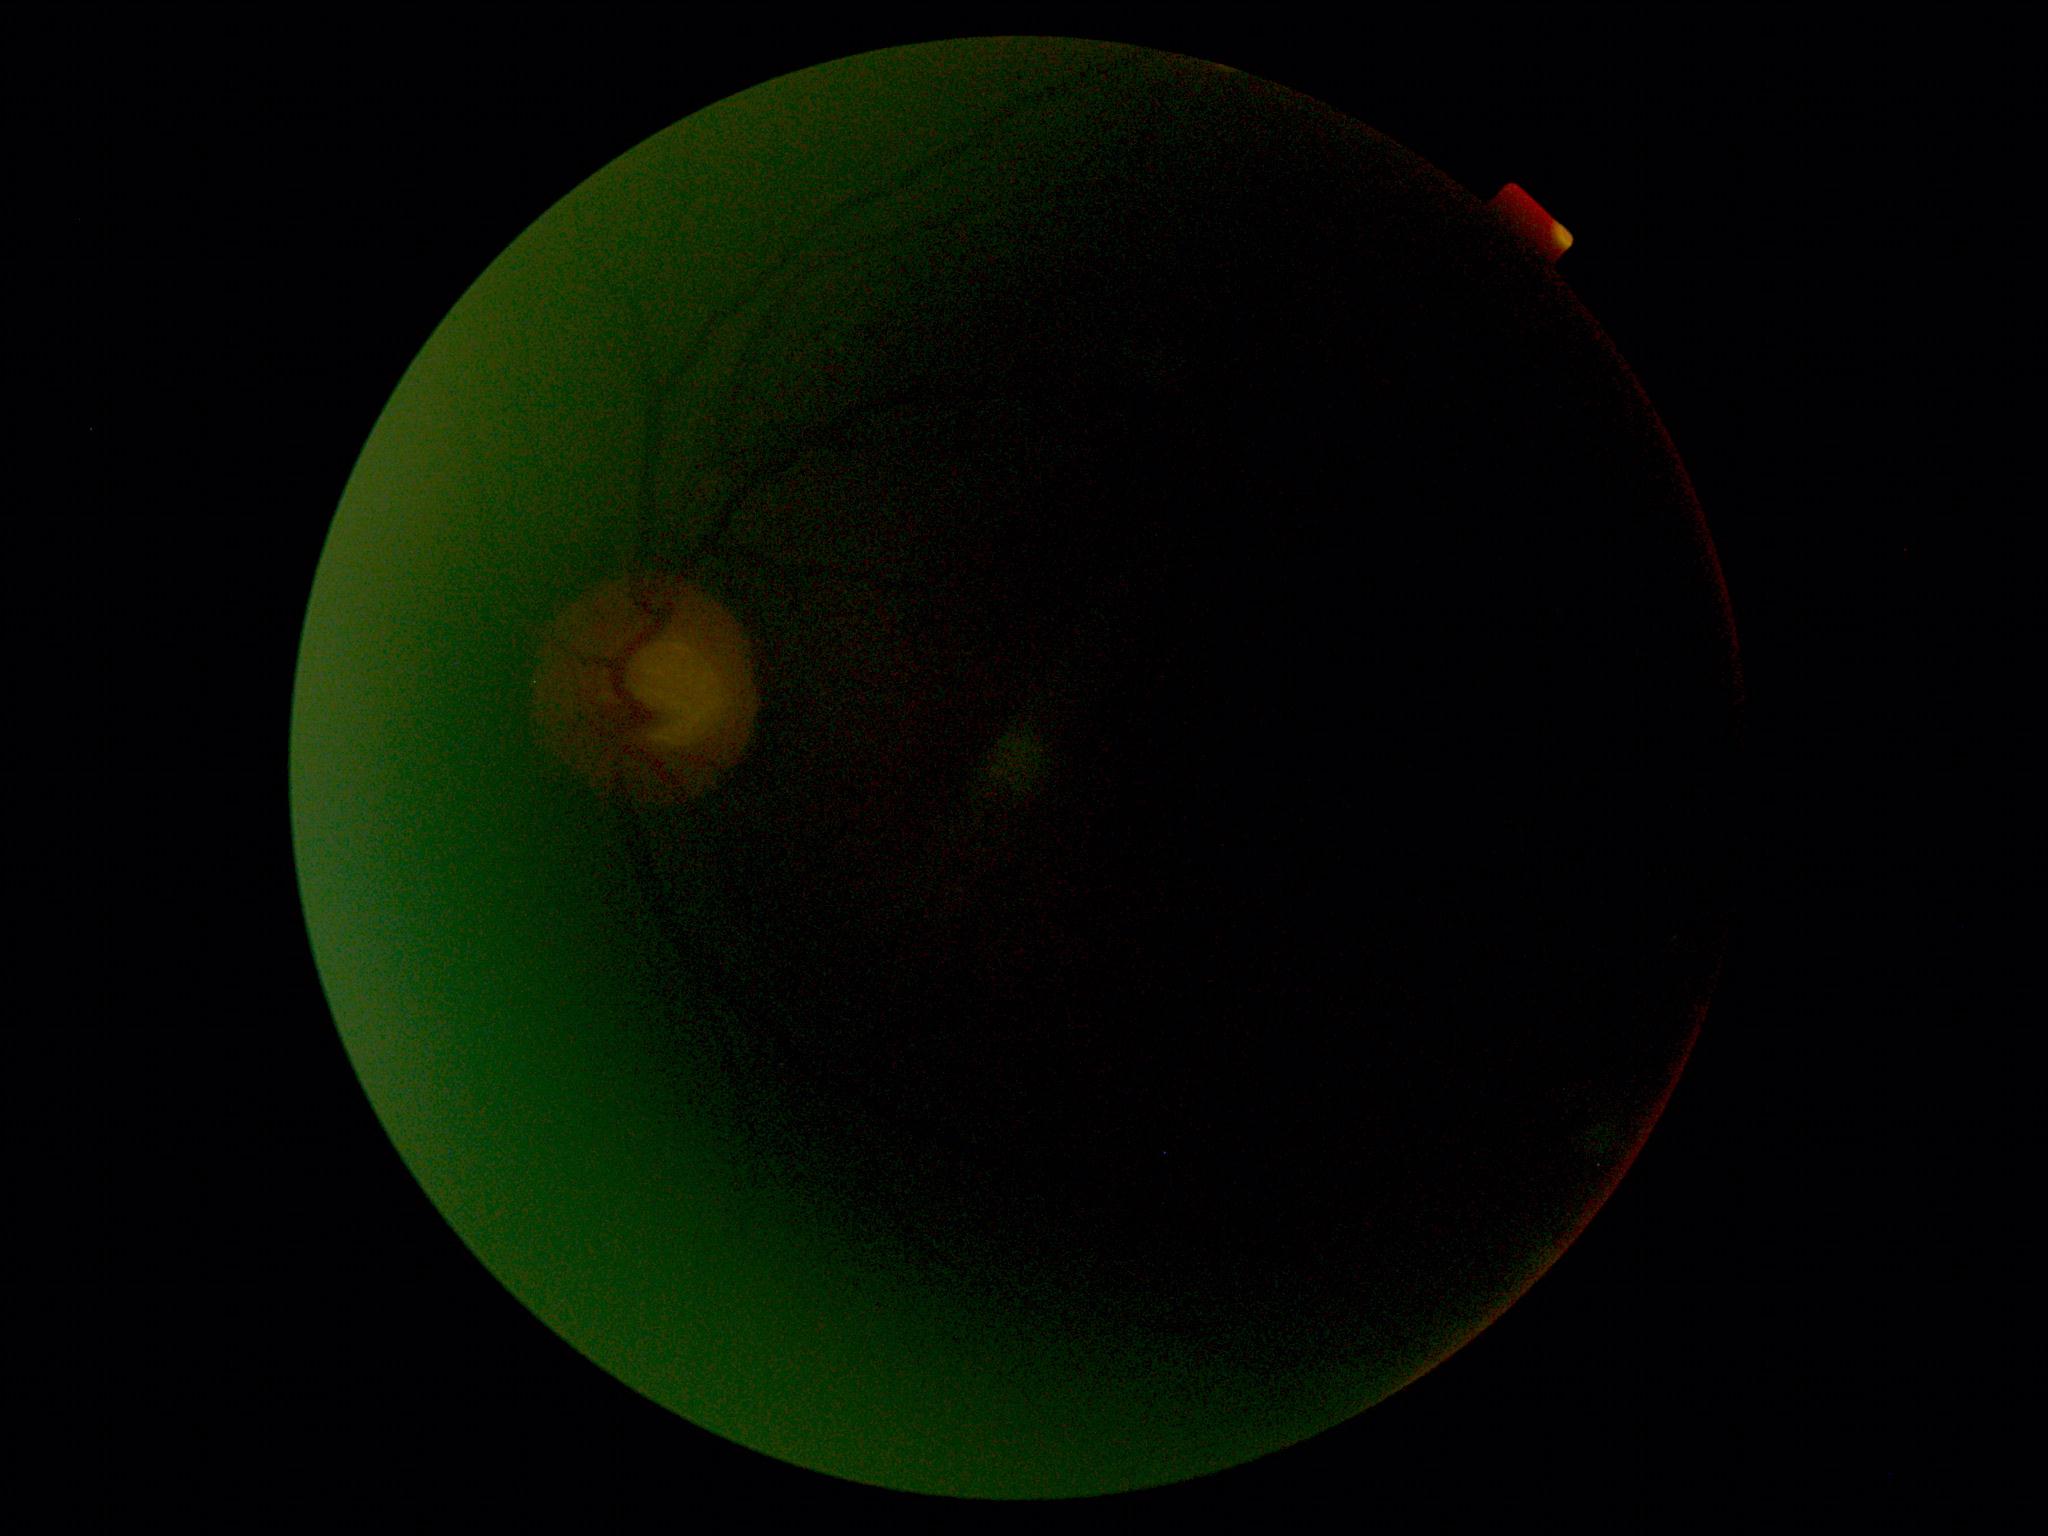 quality: insufficient for DR assessment
dr_grade: ungradable due to poor image quality